Wide-field contact fundus photograph of an infant; image size 640x480.
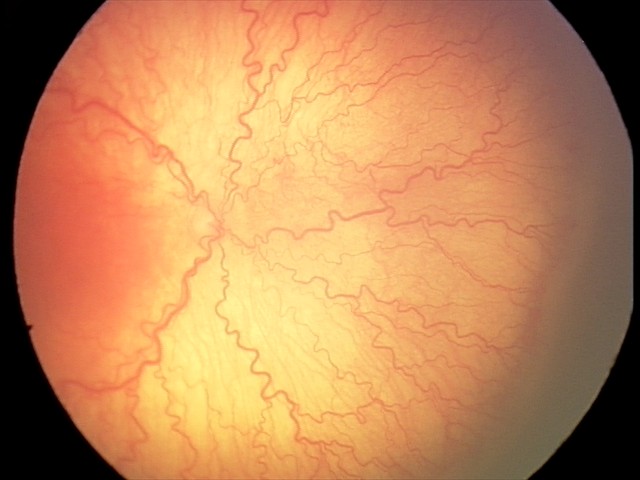 With plus disease. Screening series with aggressive retinopathy of prematurity (A-ROP).